Acquired on the Phoenix ICON · pediatric wide-field fundus photograph — 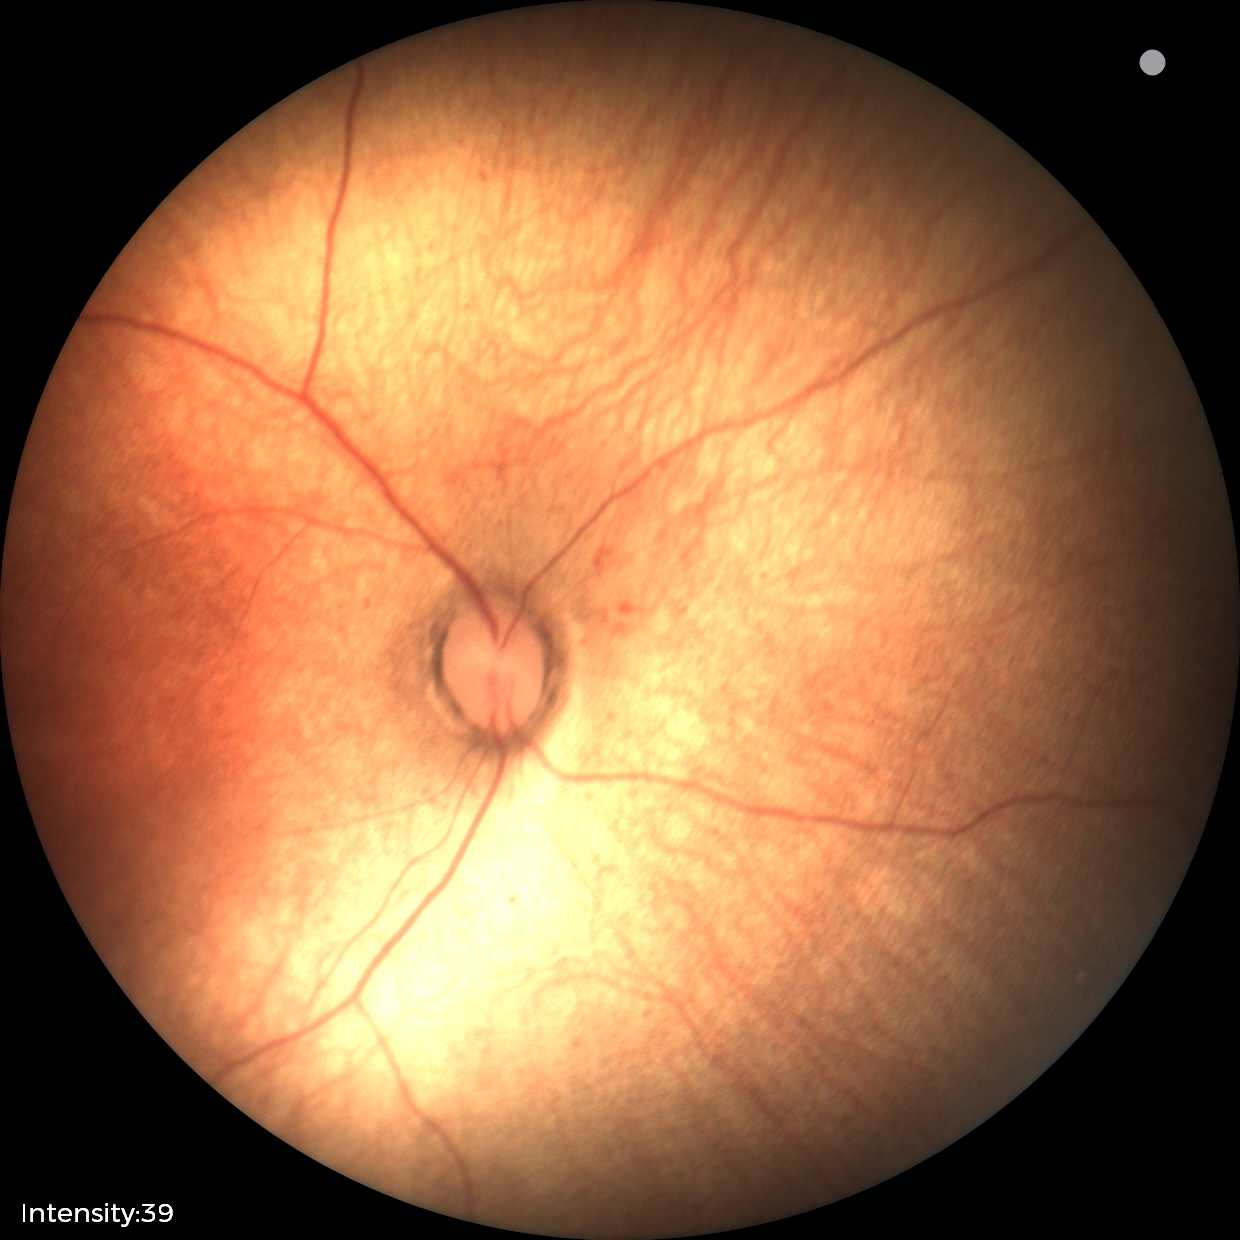
Impression: normal retinal appearance.